Color fundus photograph — 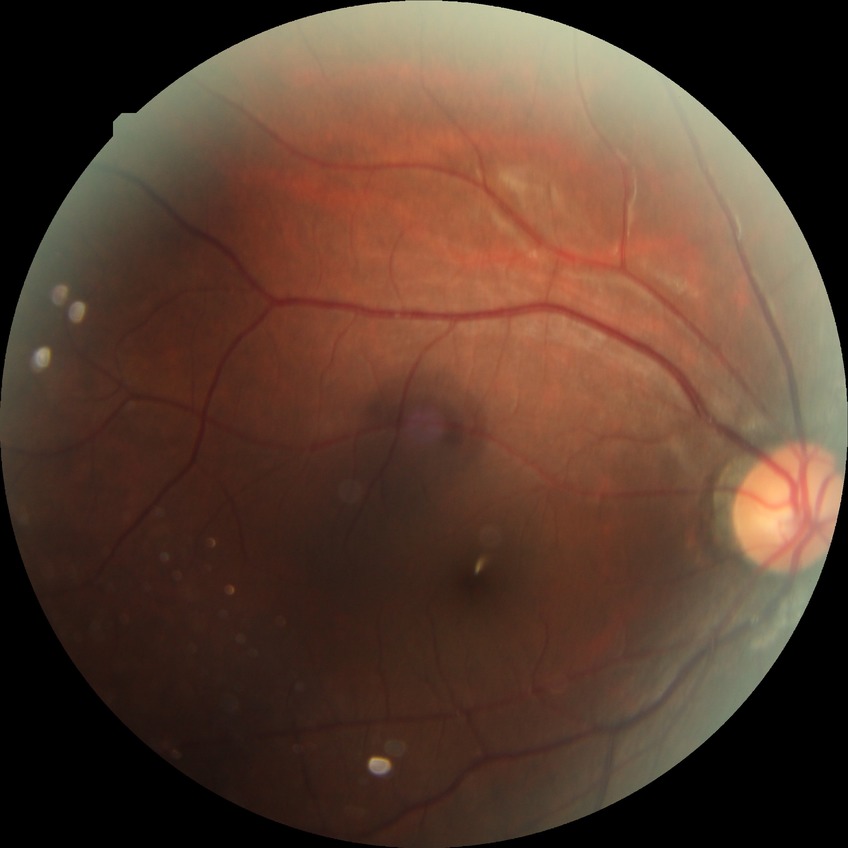
Diabetic retinopathy severity: no diabetic retinopathy.